45° FOV.
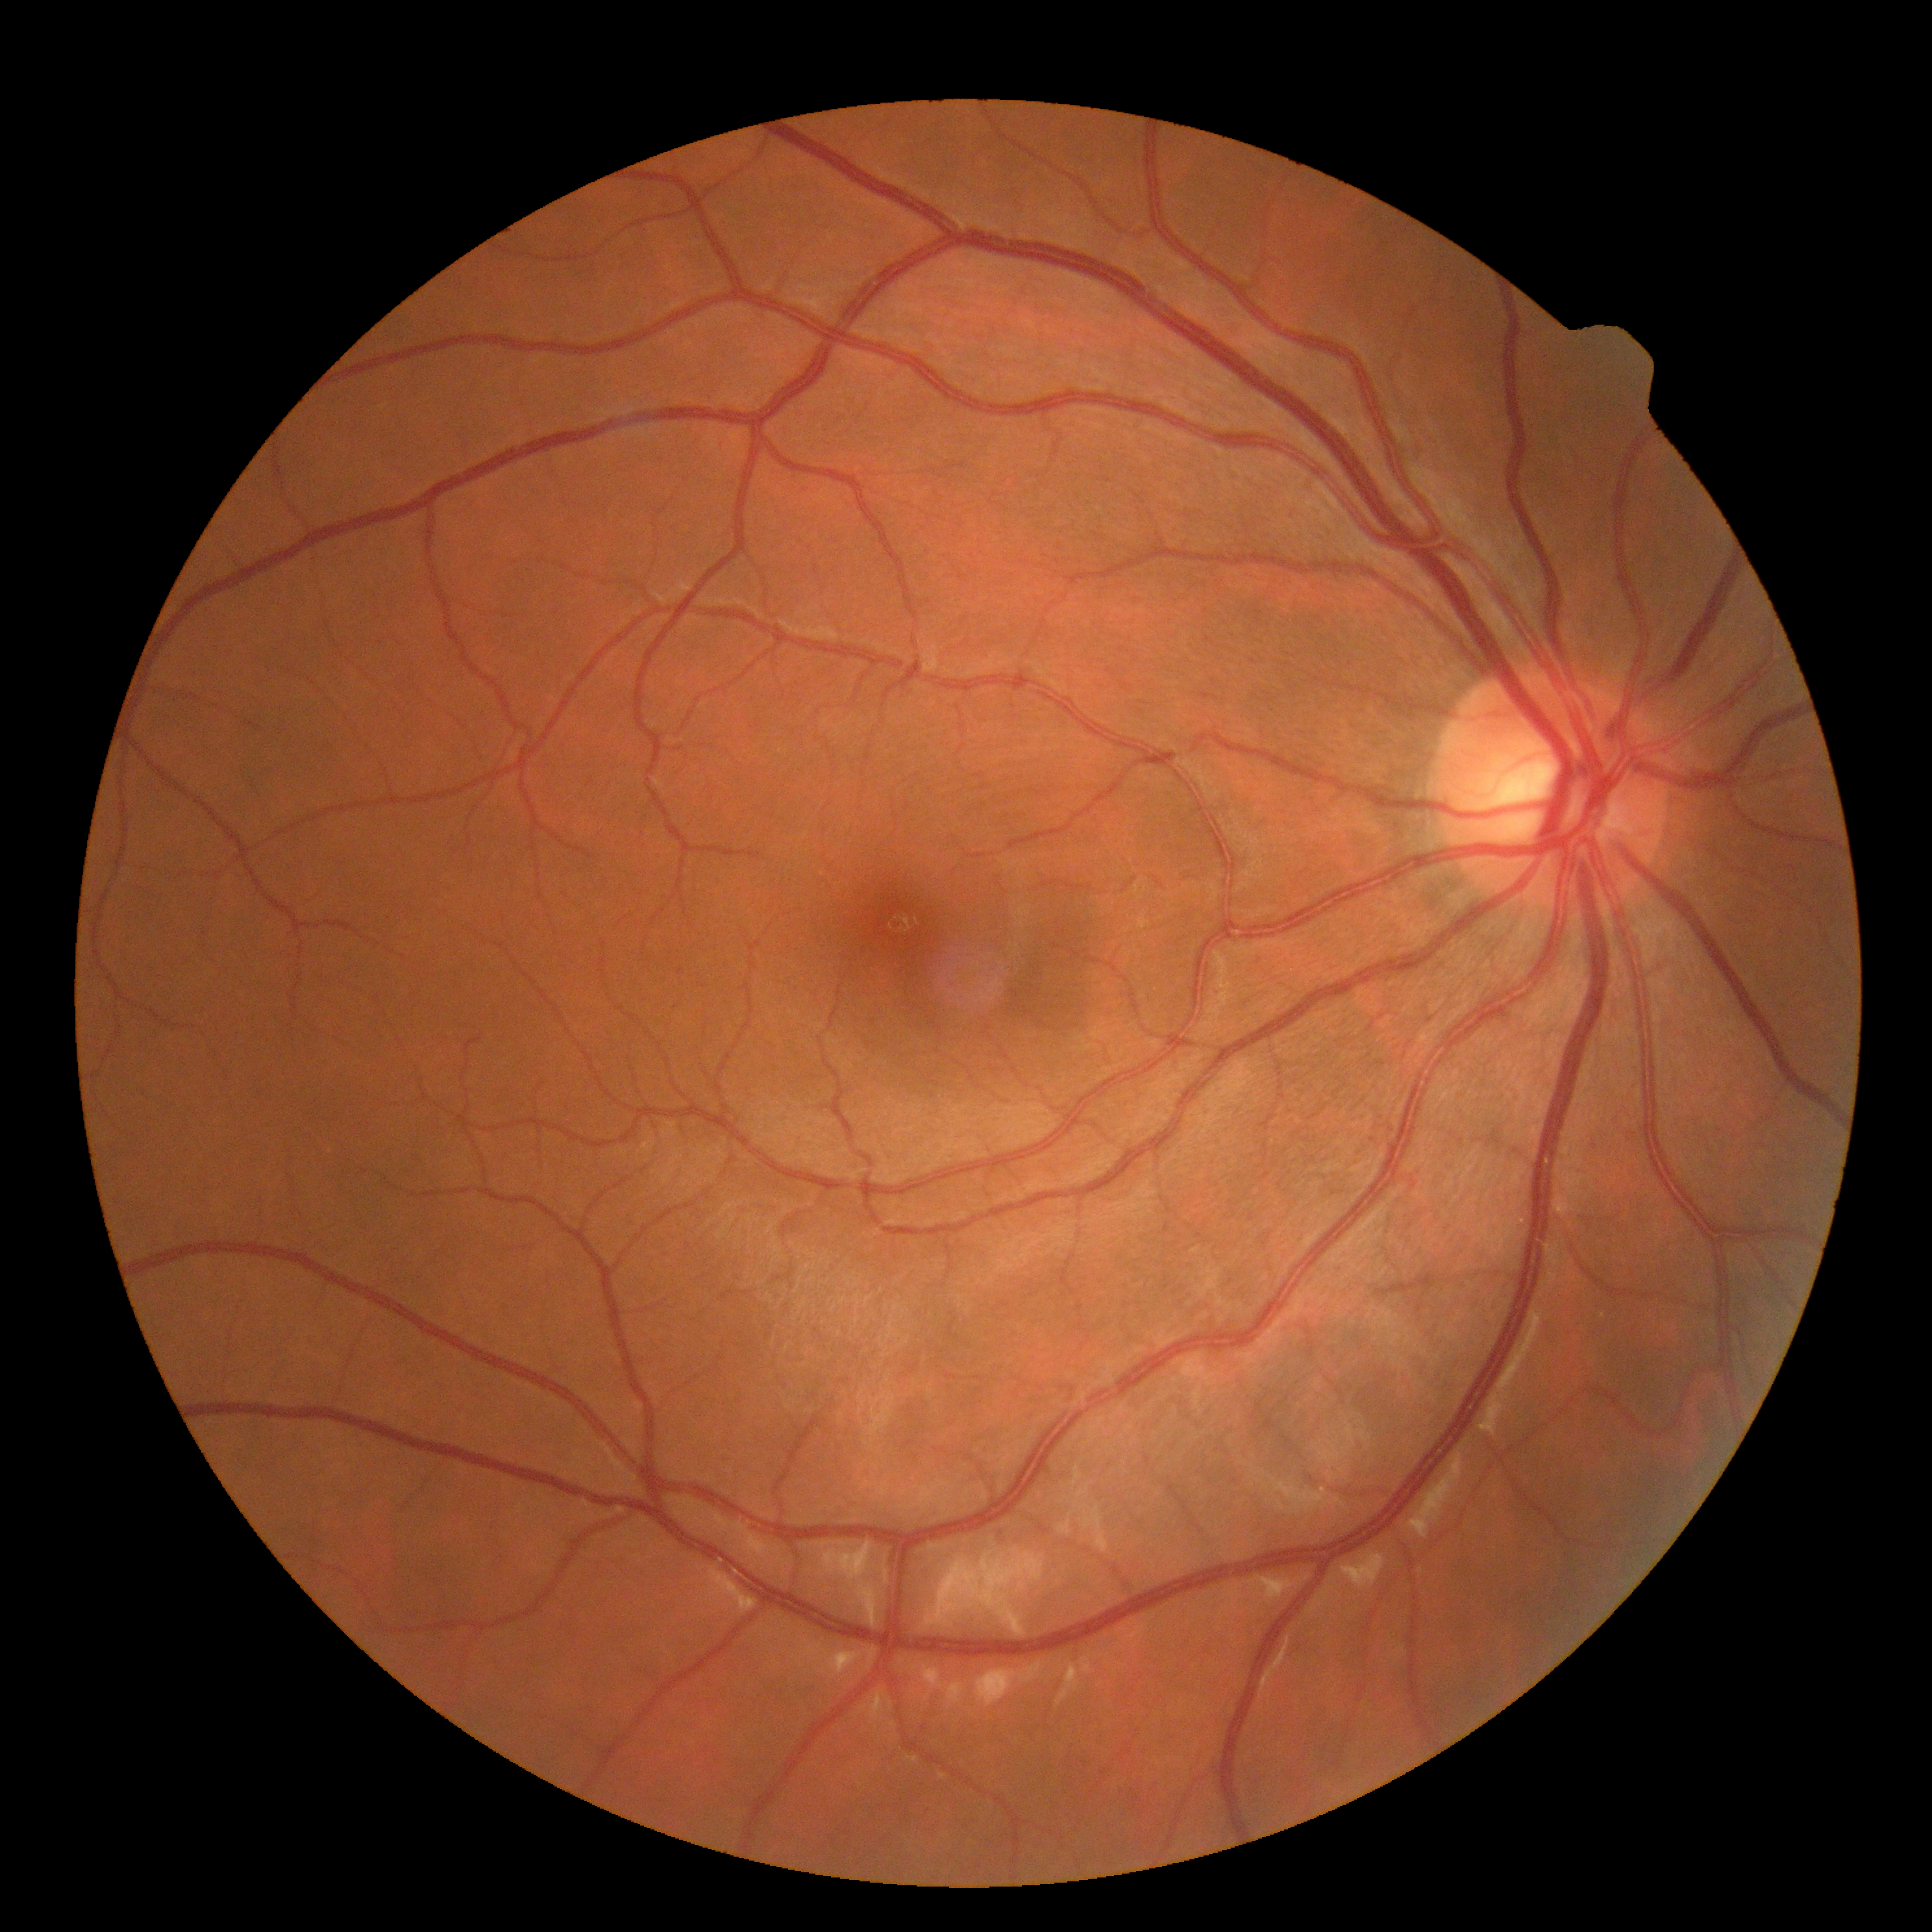
DR impression=no apparent DR; retinopathy=no apparent retinopathy (grade 0).